No pharmacologic dilation.
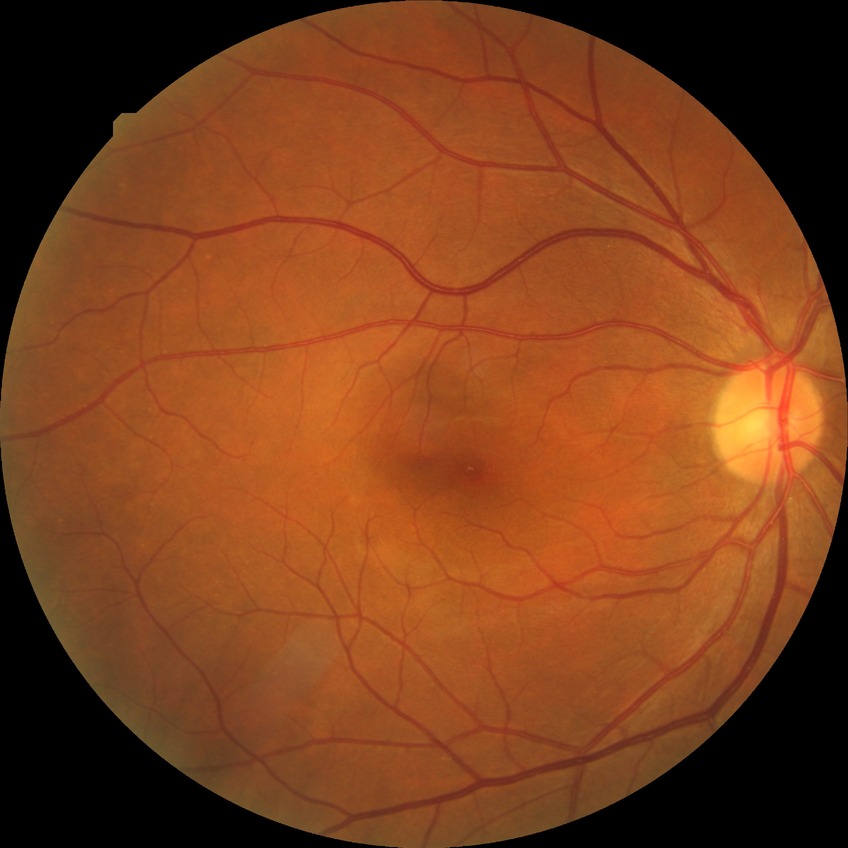
Diabetic retinopathy stage is simple diabetic retinopathy.